848x848px; diabetic retinopathy graded by the modified Davis classification: 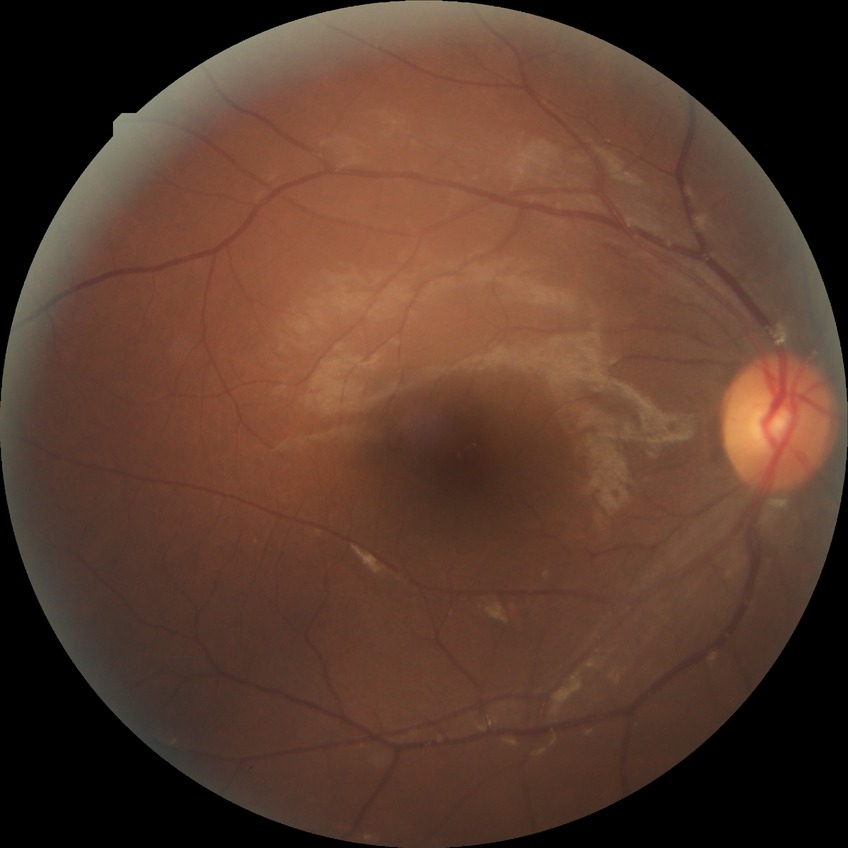

diabetic retinopathy (DR)=SDR (simple diabetic retinopathy).